Wide-field contact fundus photograph of an infant · image size 1240x1240 · camera: Phoenix ICON (100° FOV).
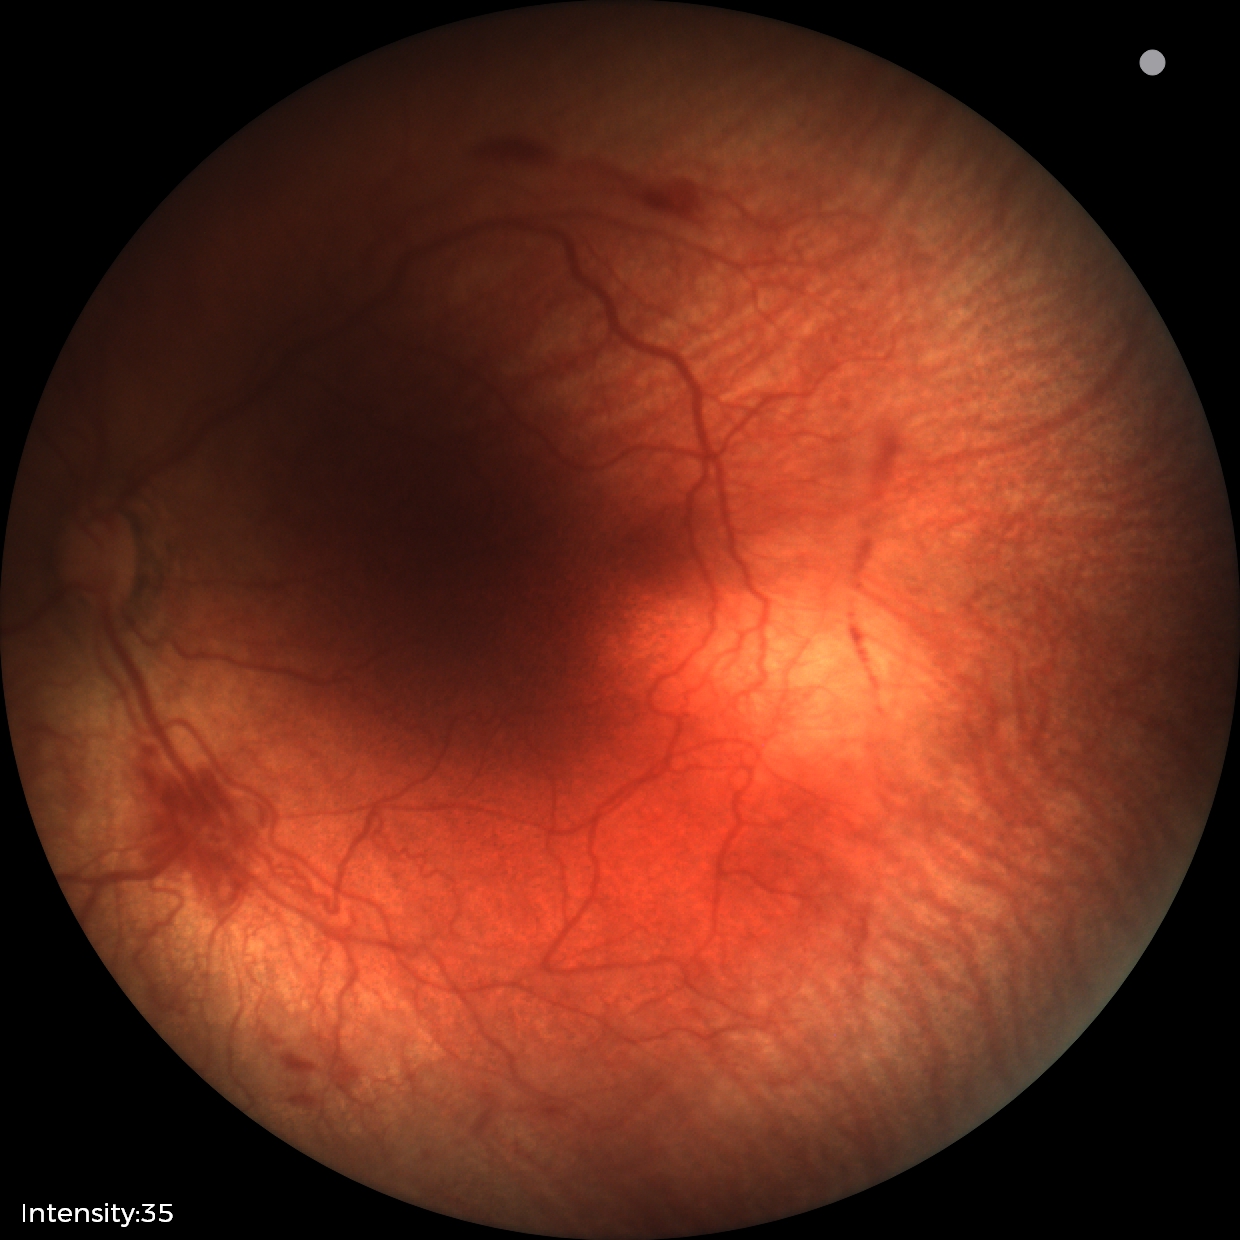

Plus disease: present | impression: retinopathy of prematurity (ROP) stage 2 — ridge with height and width at the demarcation line.